Retinal fundus photograph: 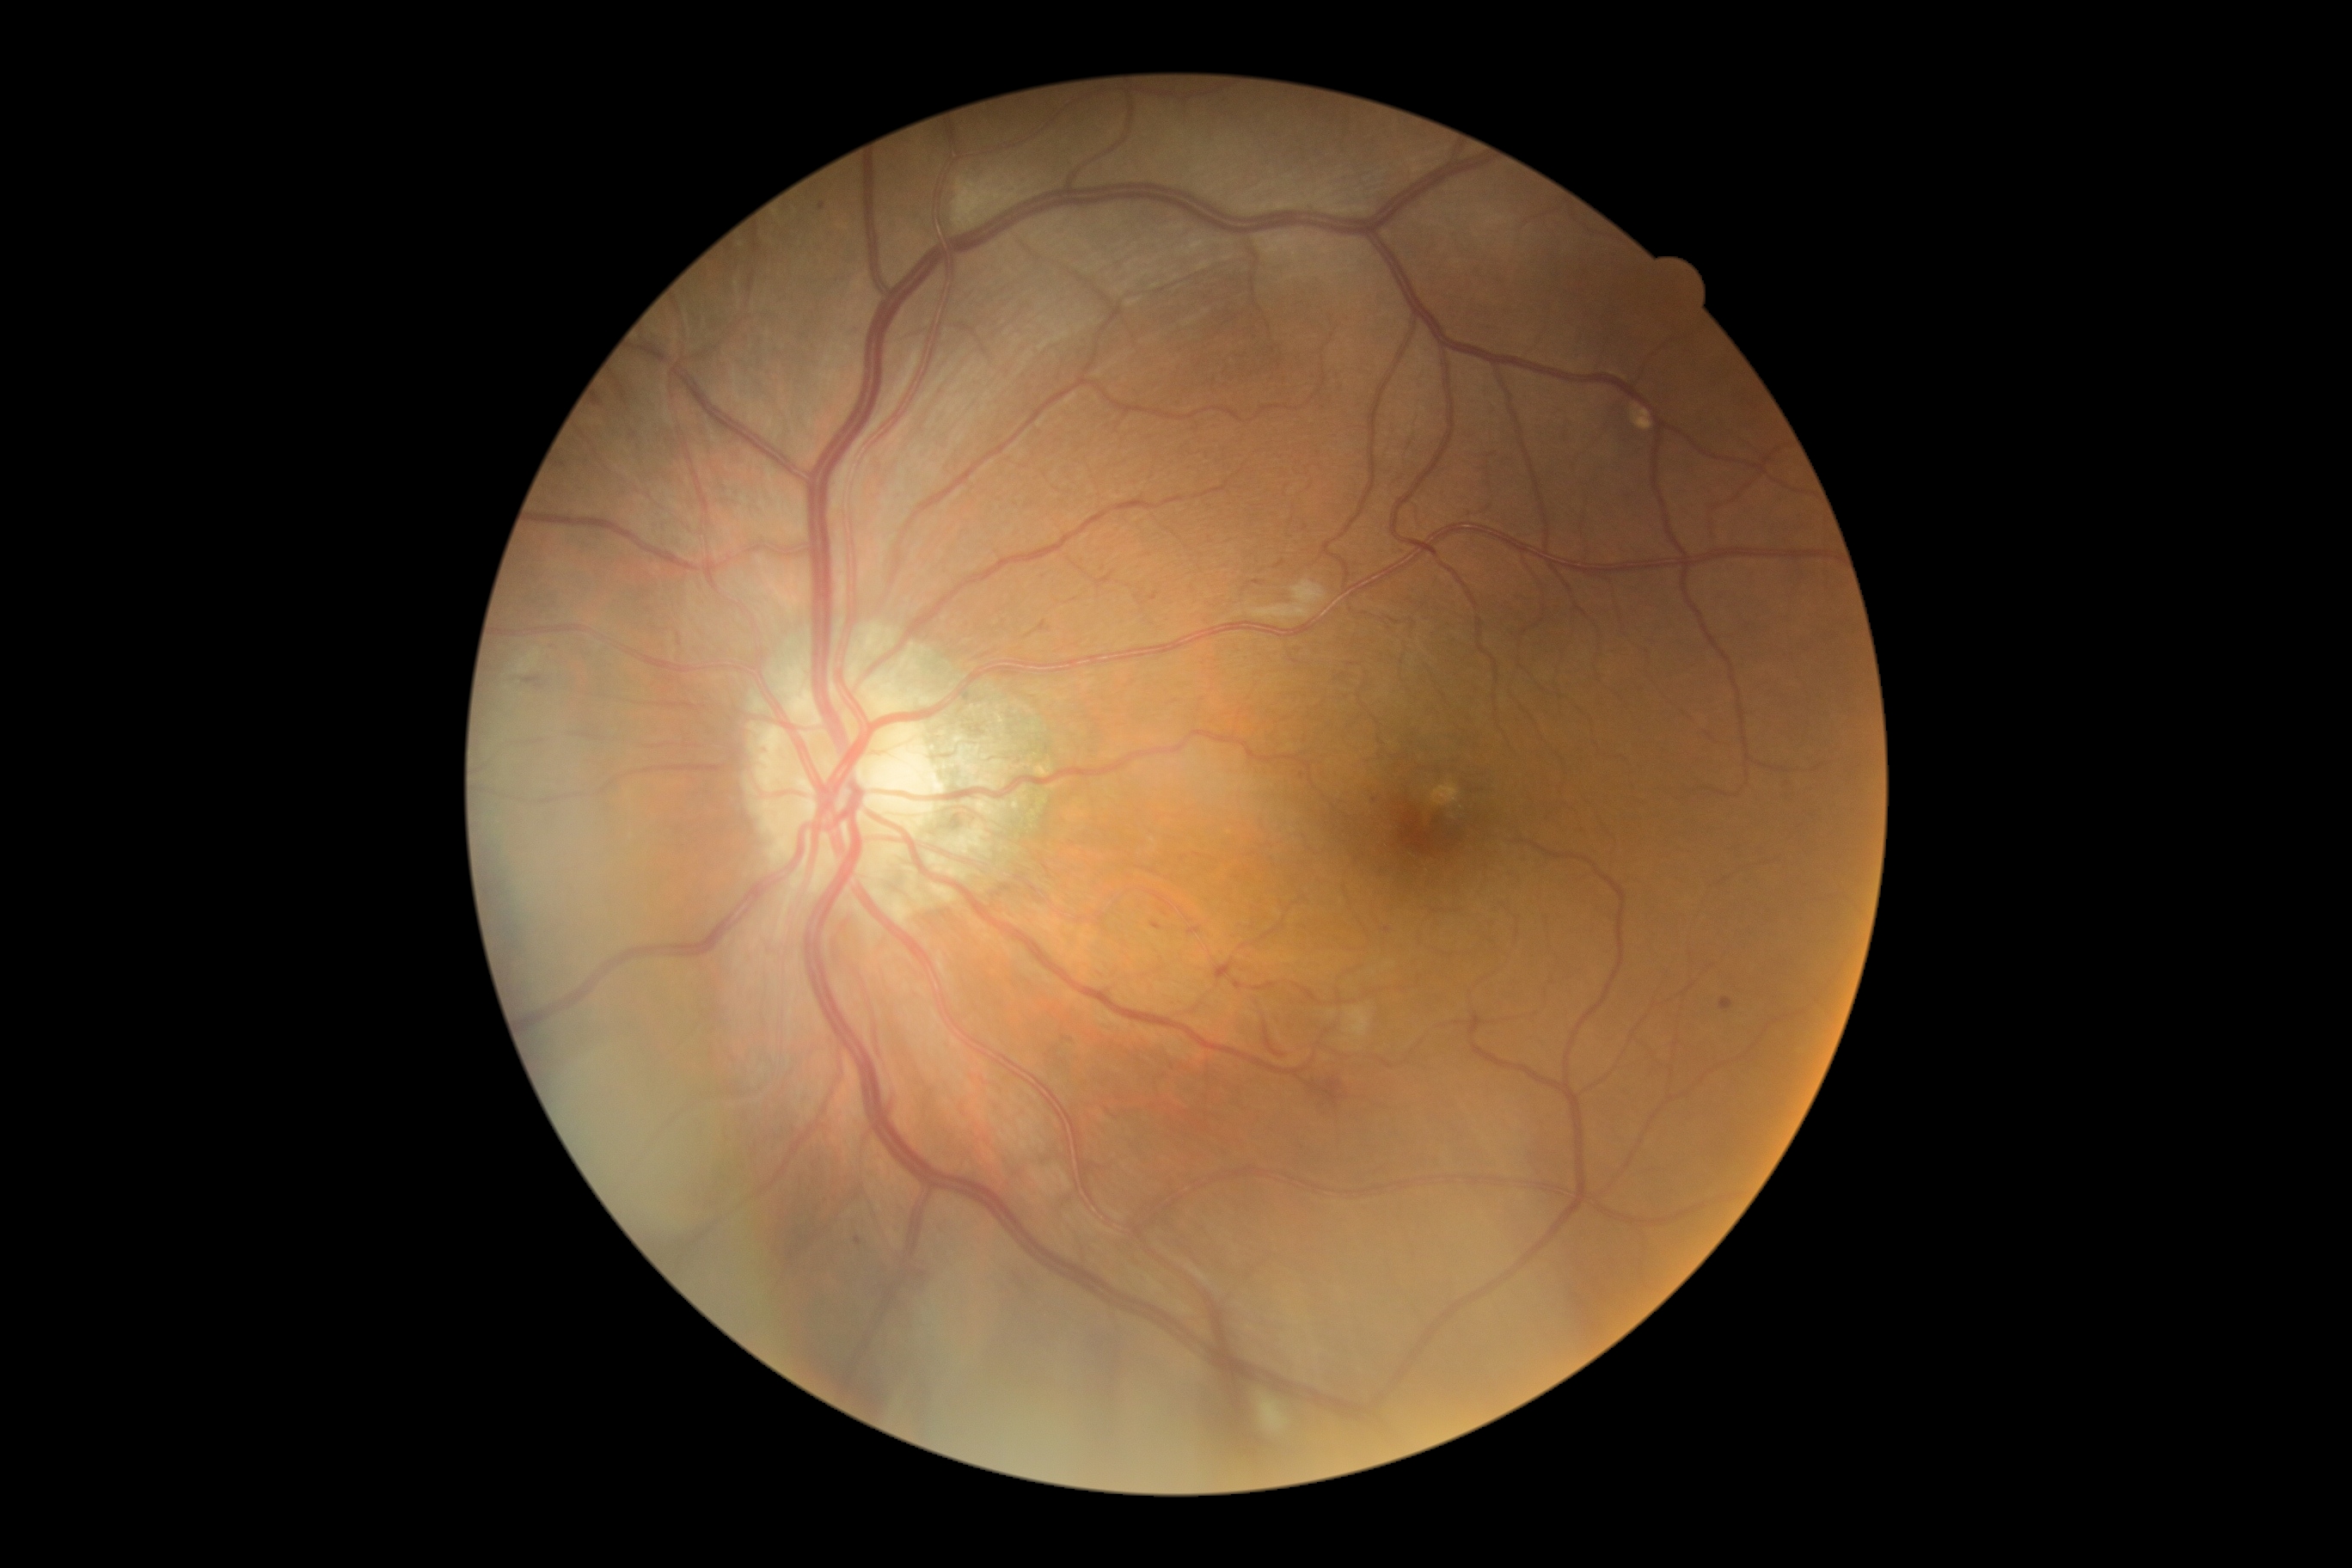 Retinopathy grade: moderate NPDR (2).